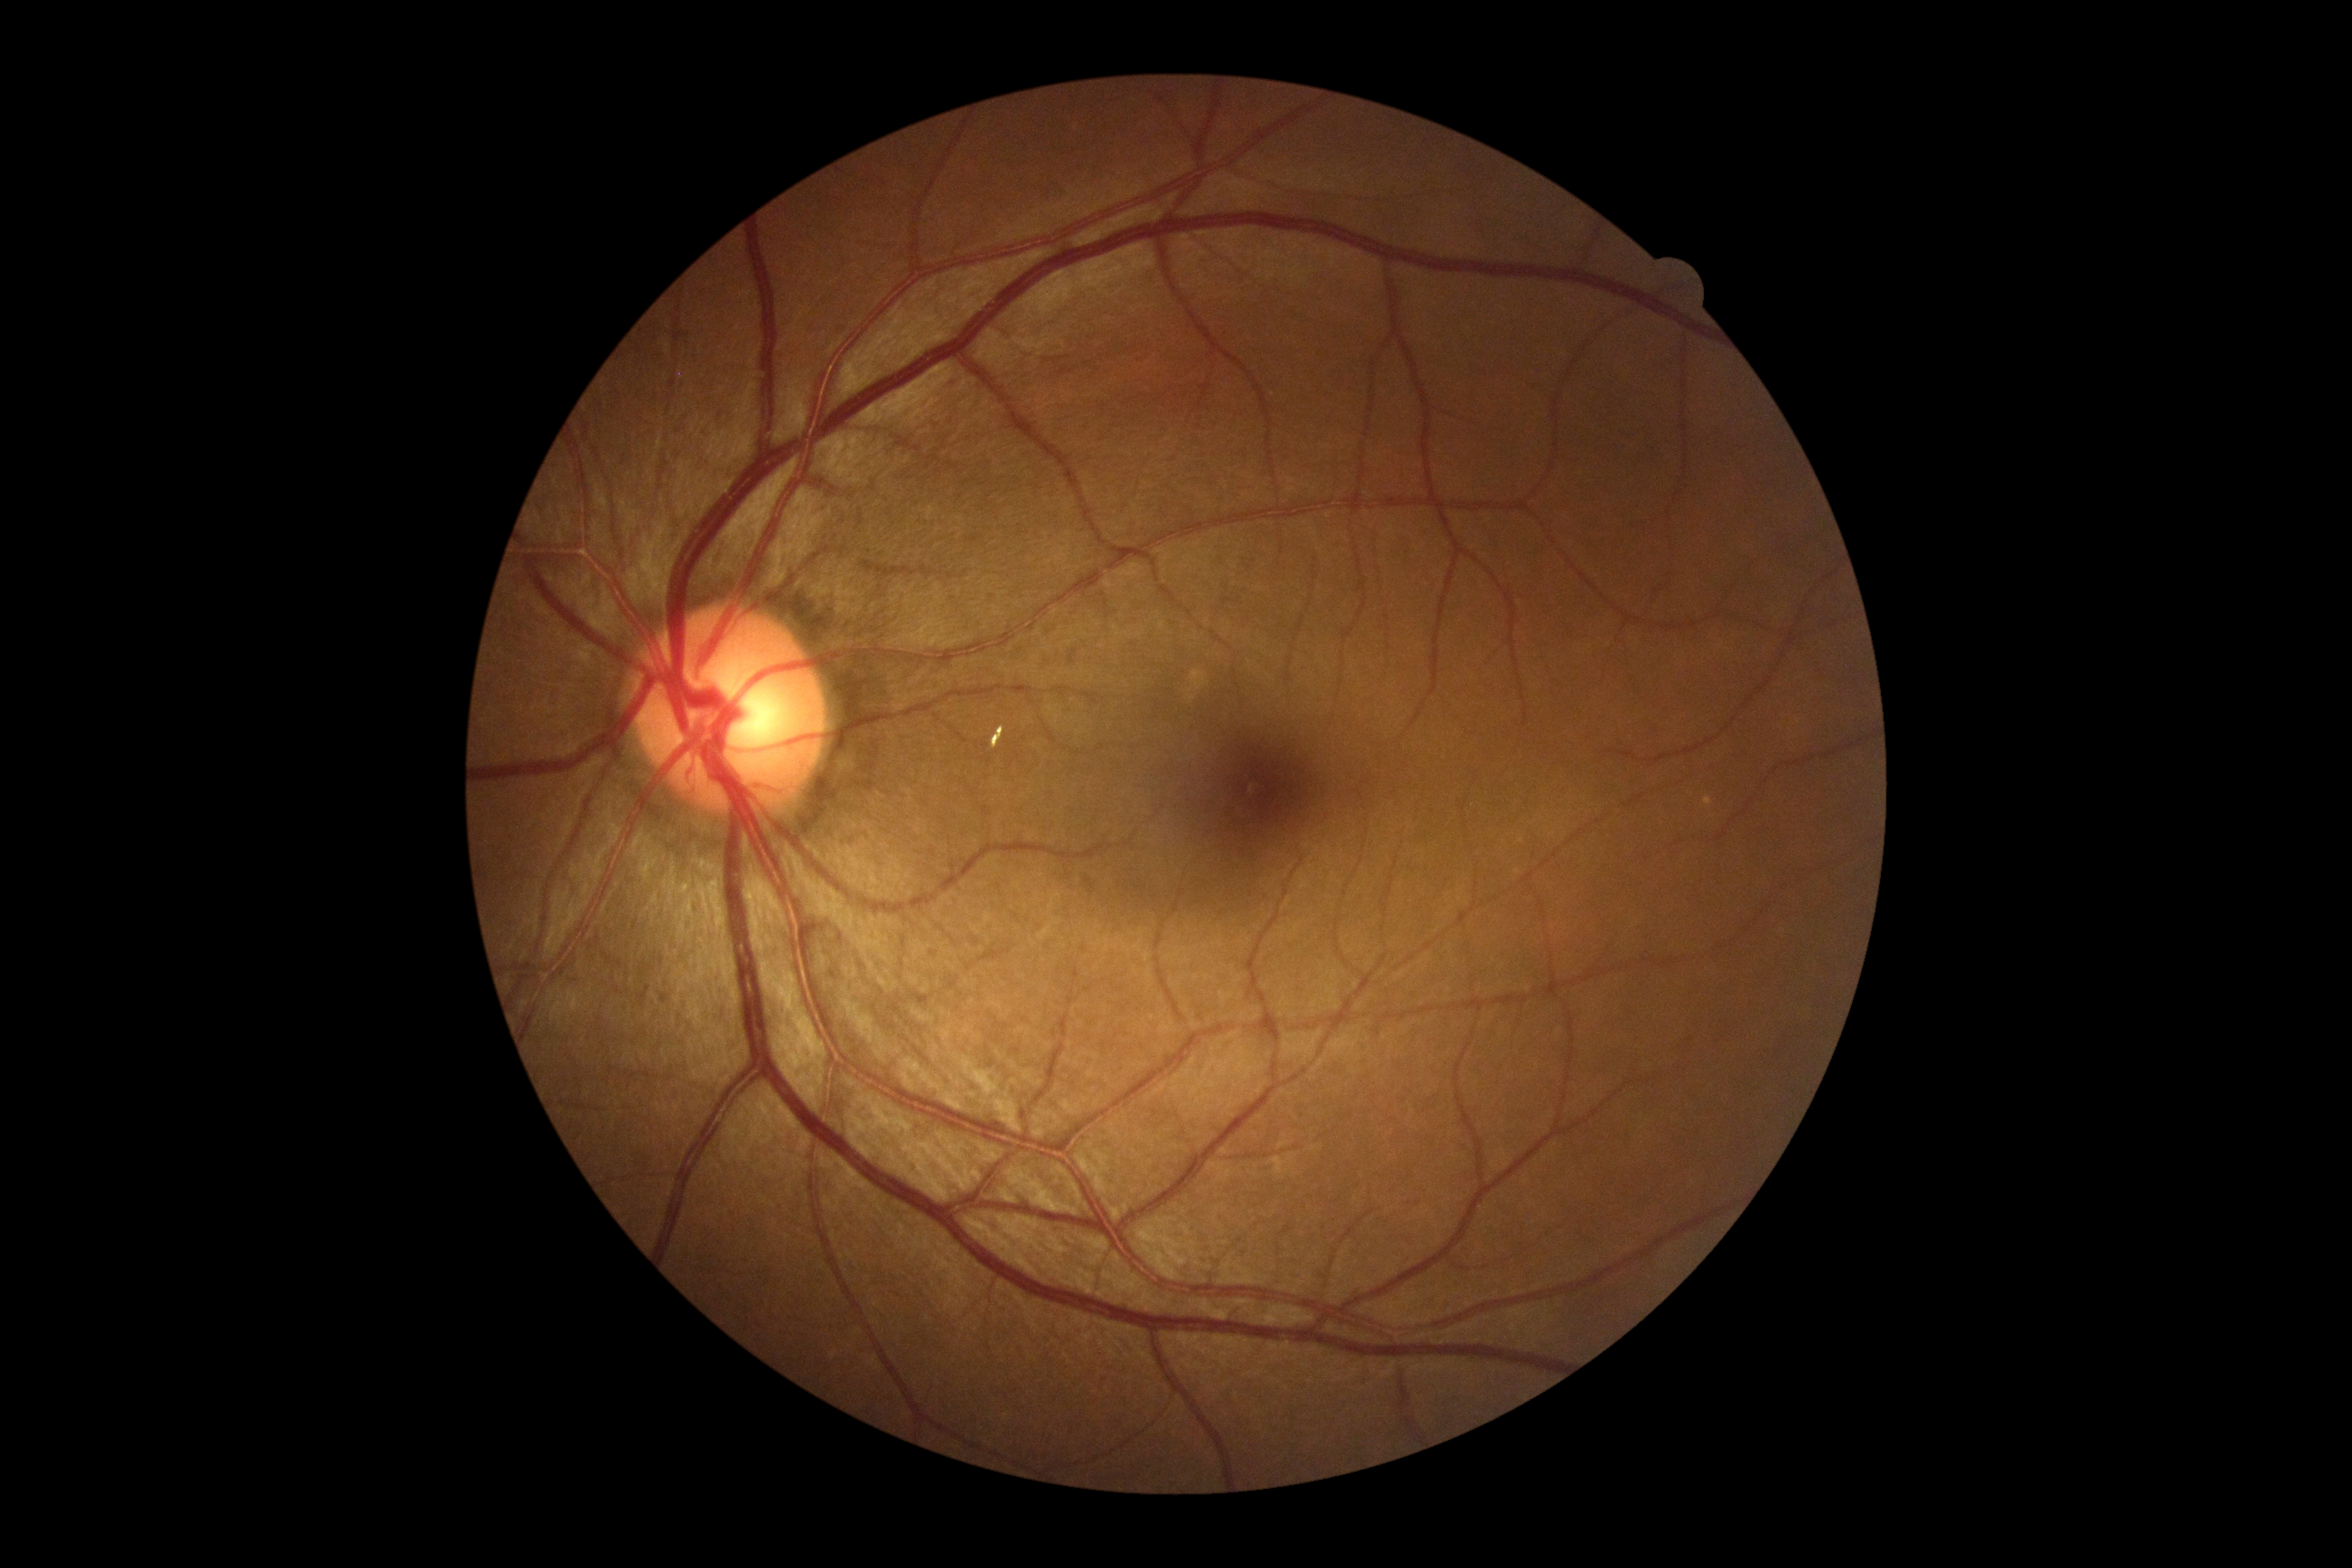
DR: 0